1659x2212 · color fundus image — 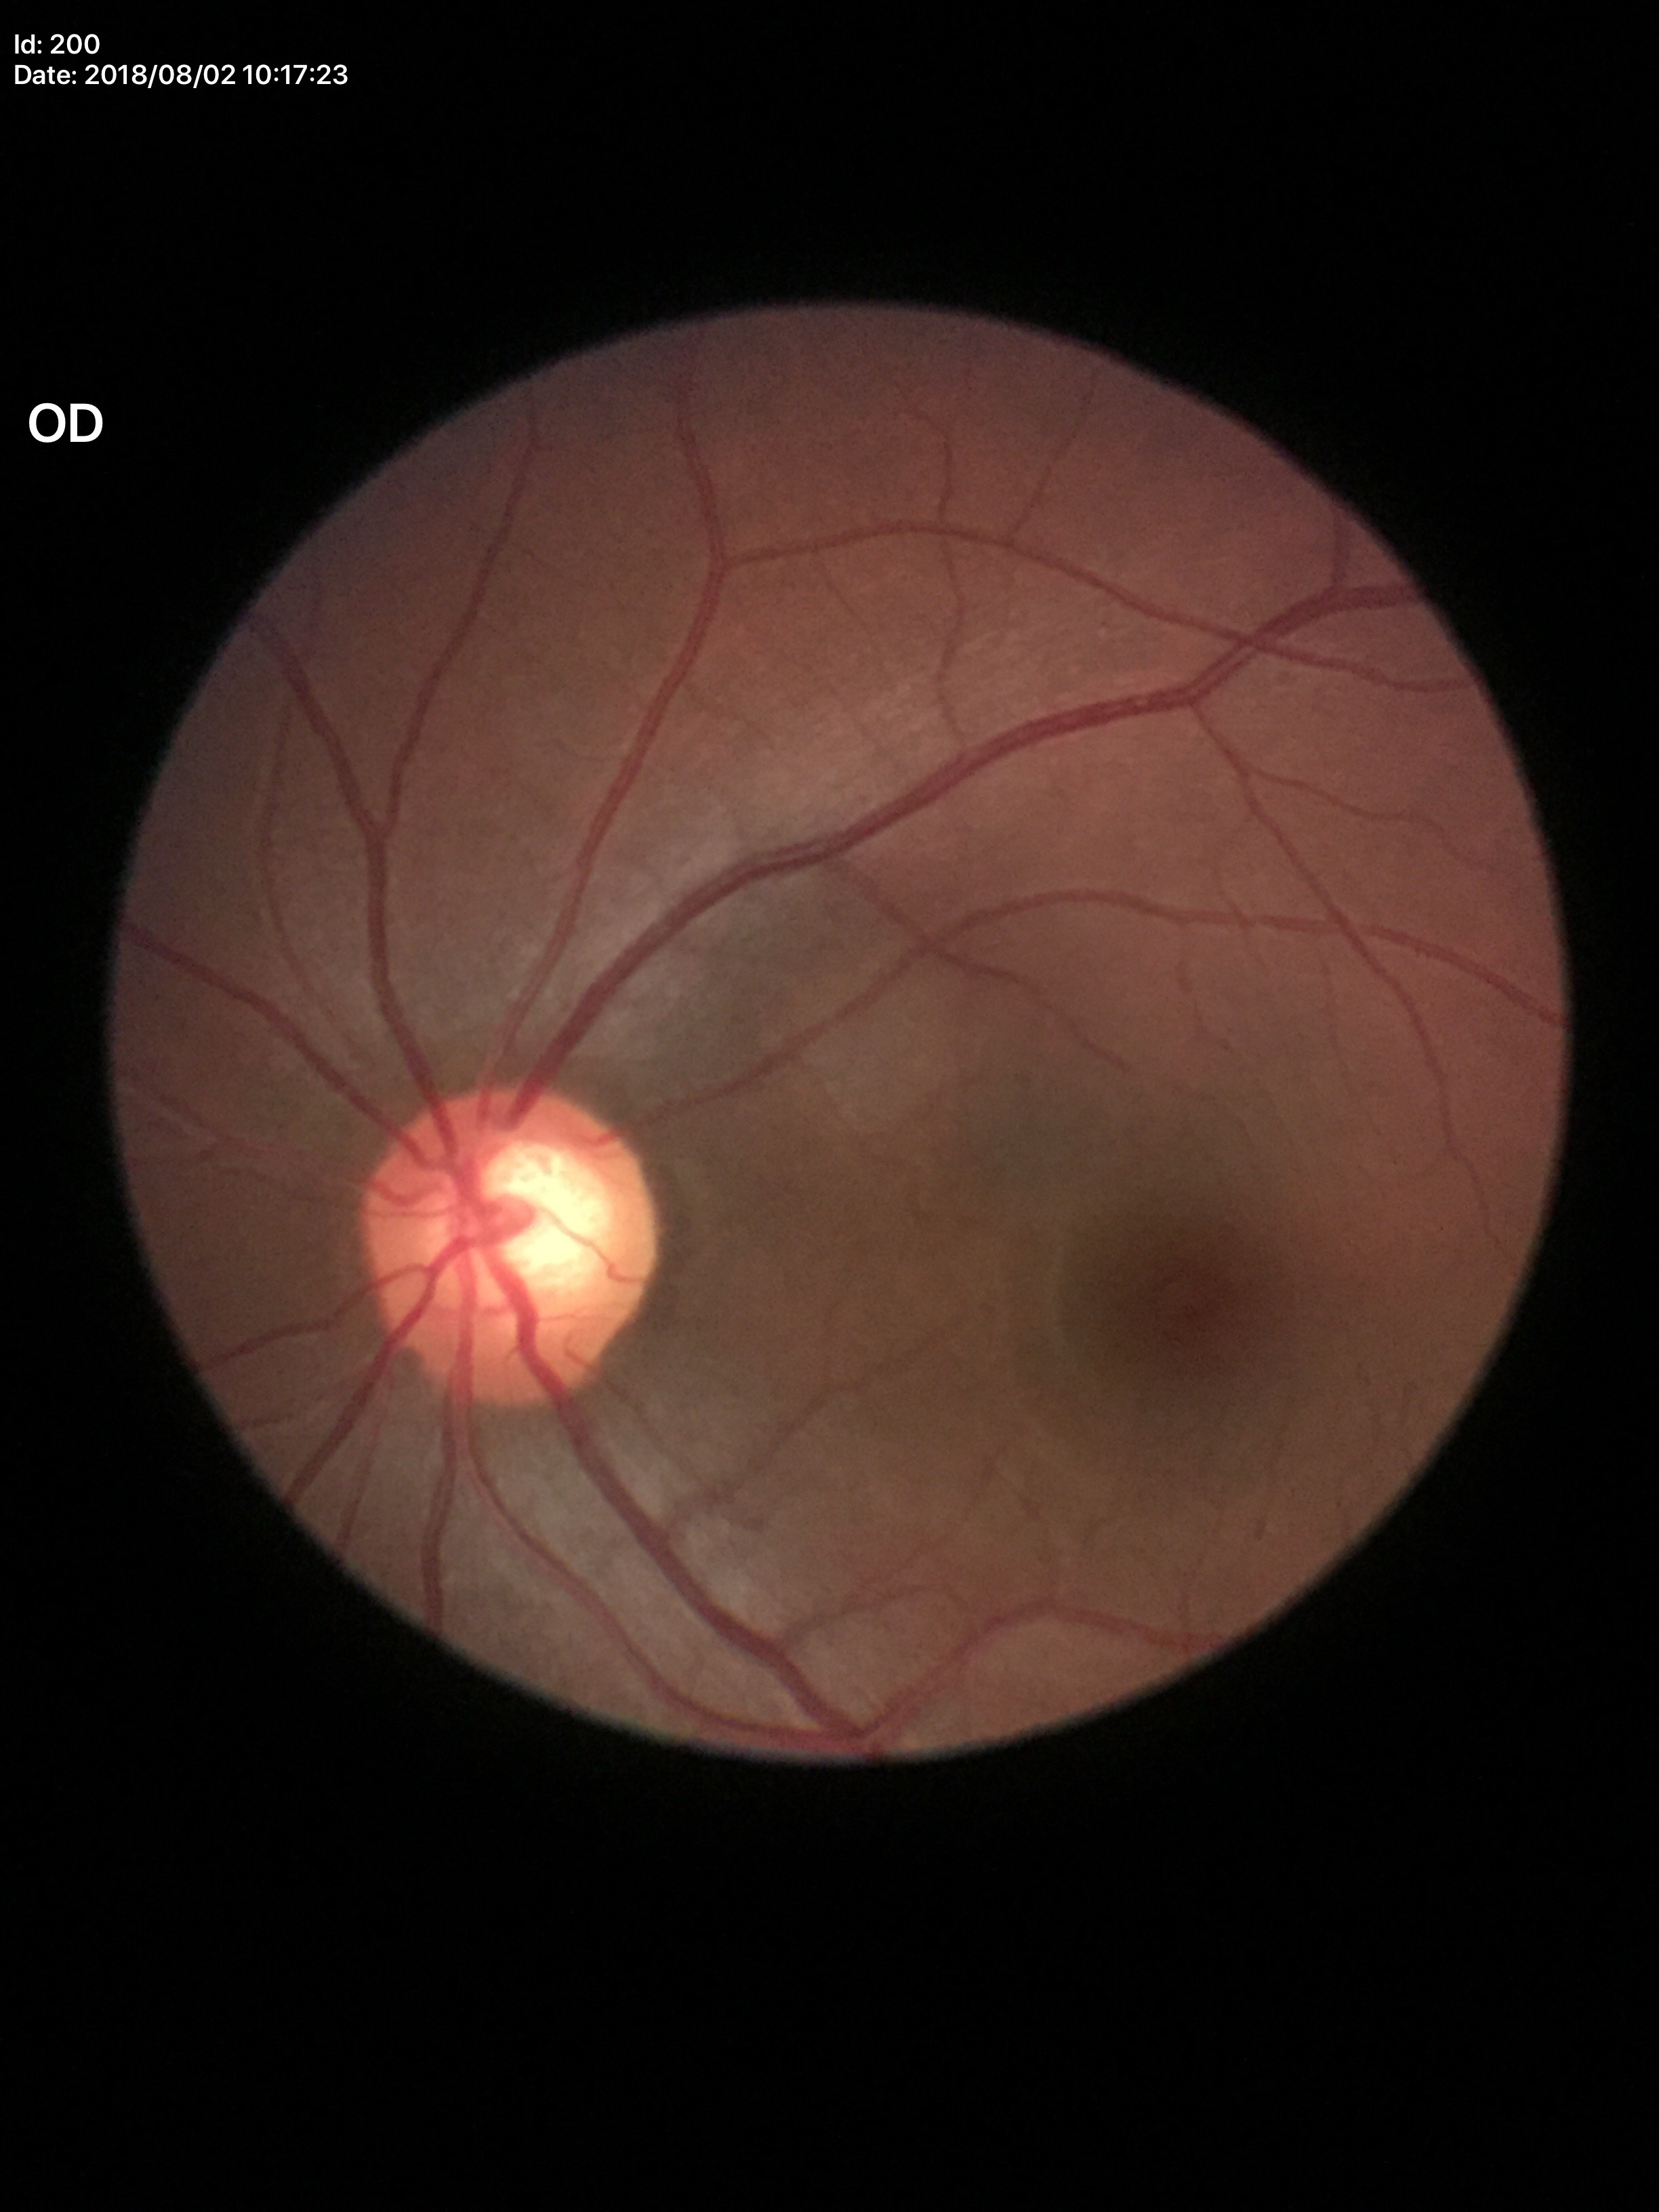

Findings:
* vertical cup-to-disc ratio (VCDR) · 0.62
* Glaucoma screening impression · suspect